1380x1382
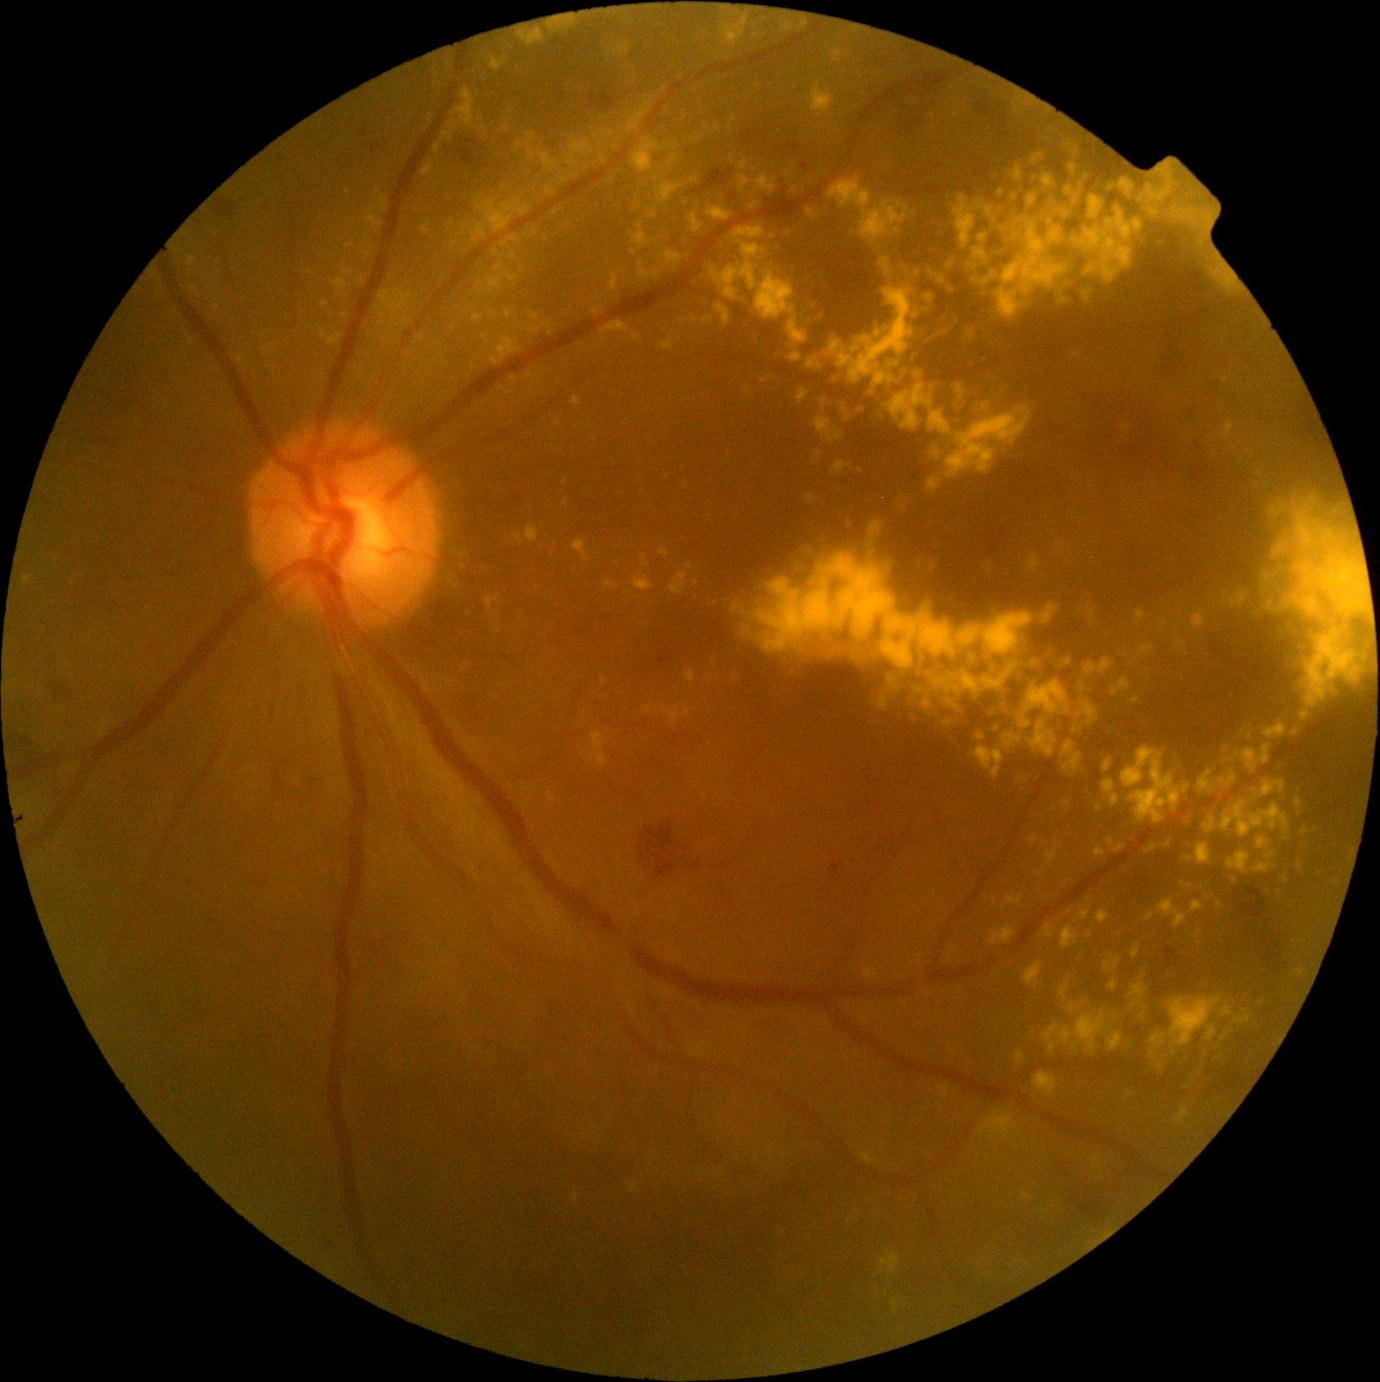 Annotations:
* DR severity — grade 2 (moderate NPDR) — more than just microaneurysms but less than severe NPDR